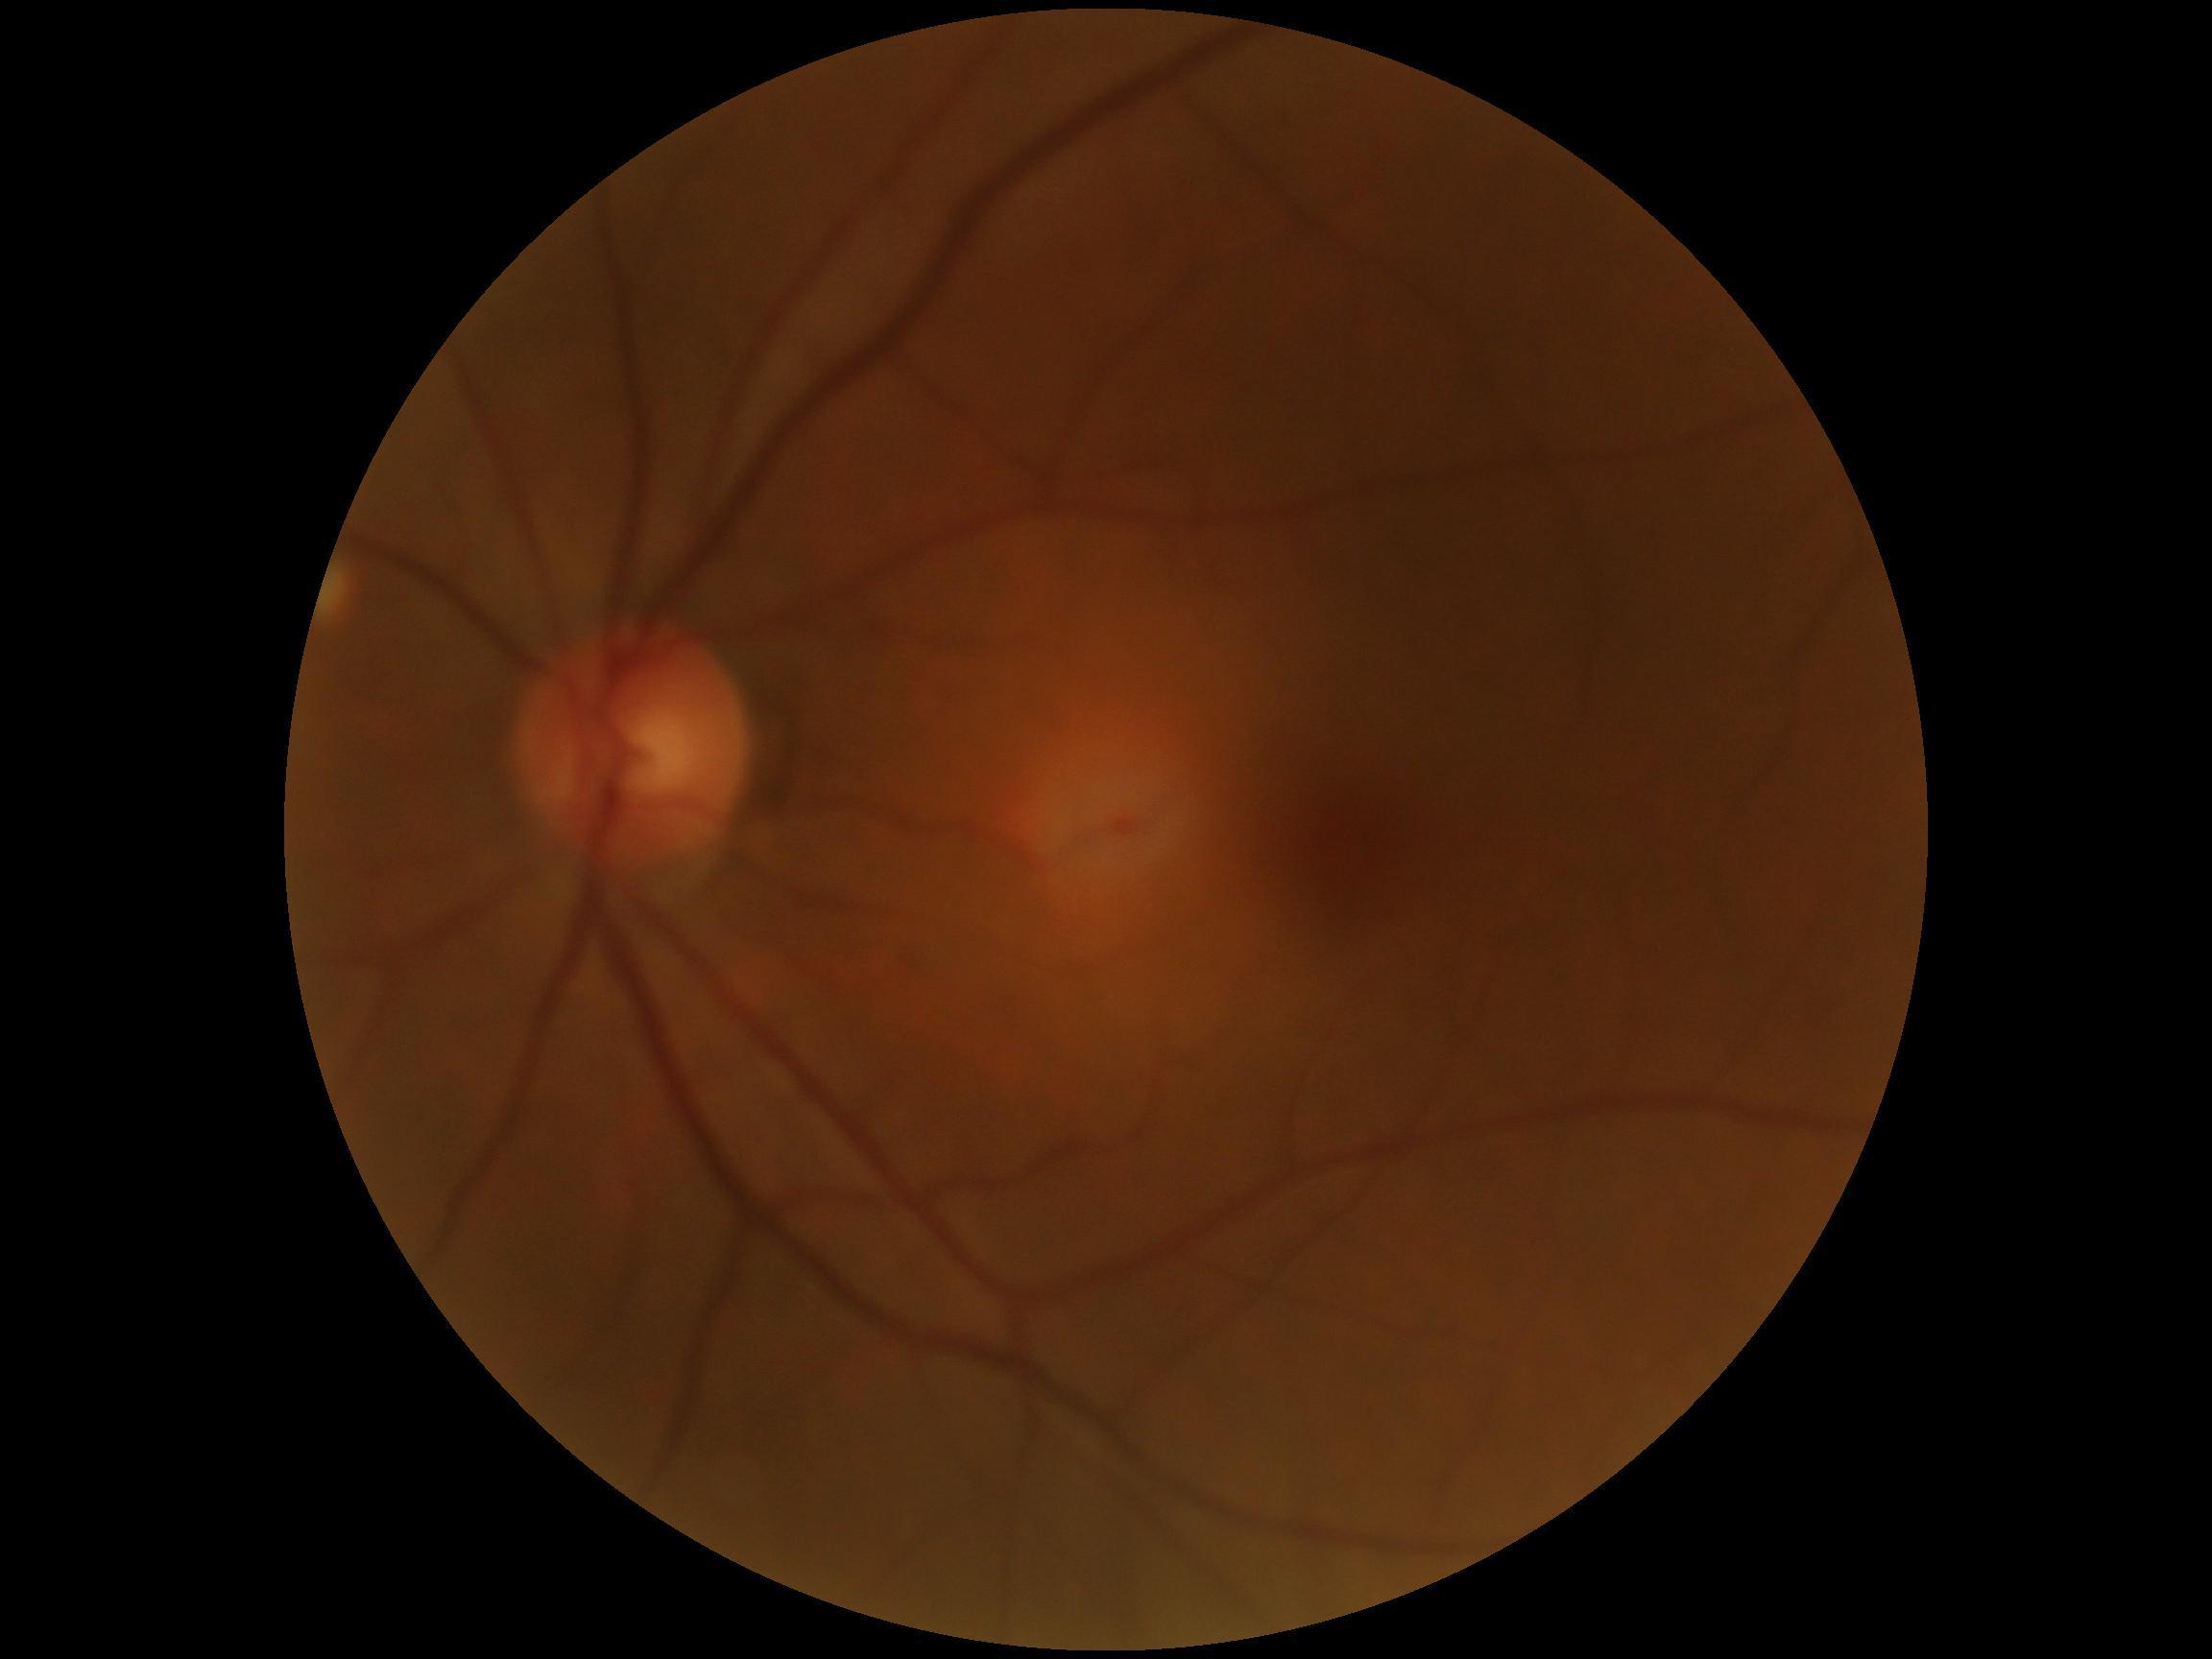 Annotations:
- DR grade — 0/4
- DR impression — negative for DR